Image size 1936x1296
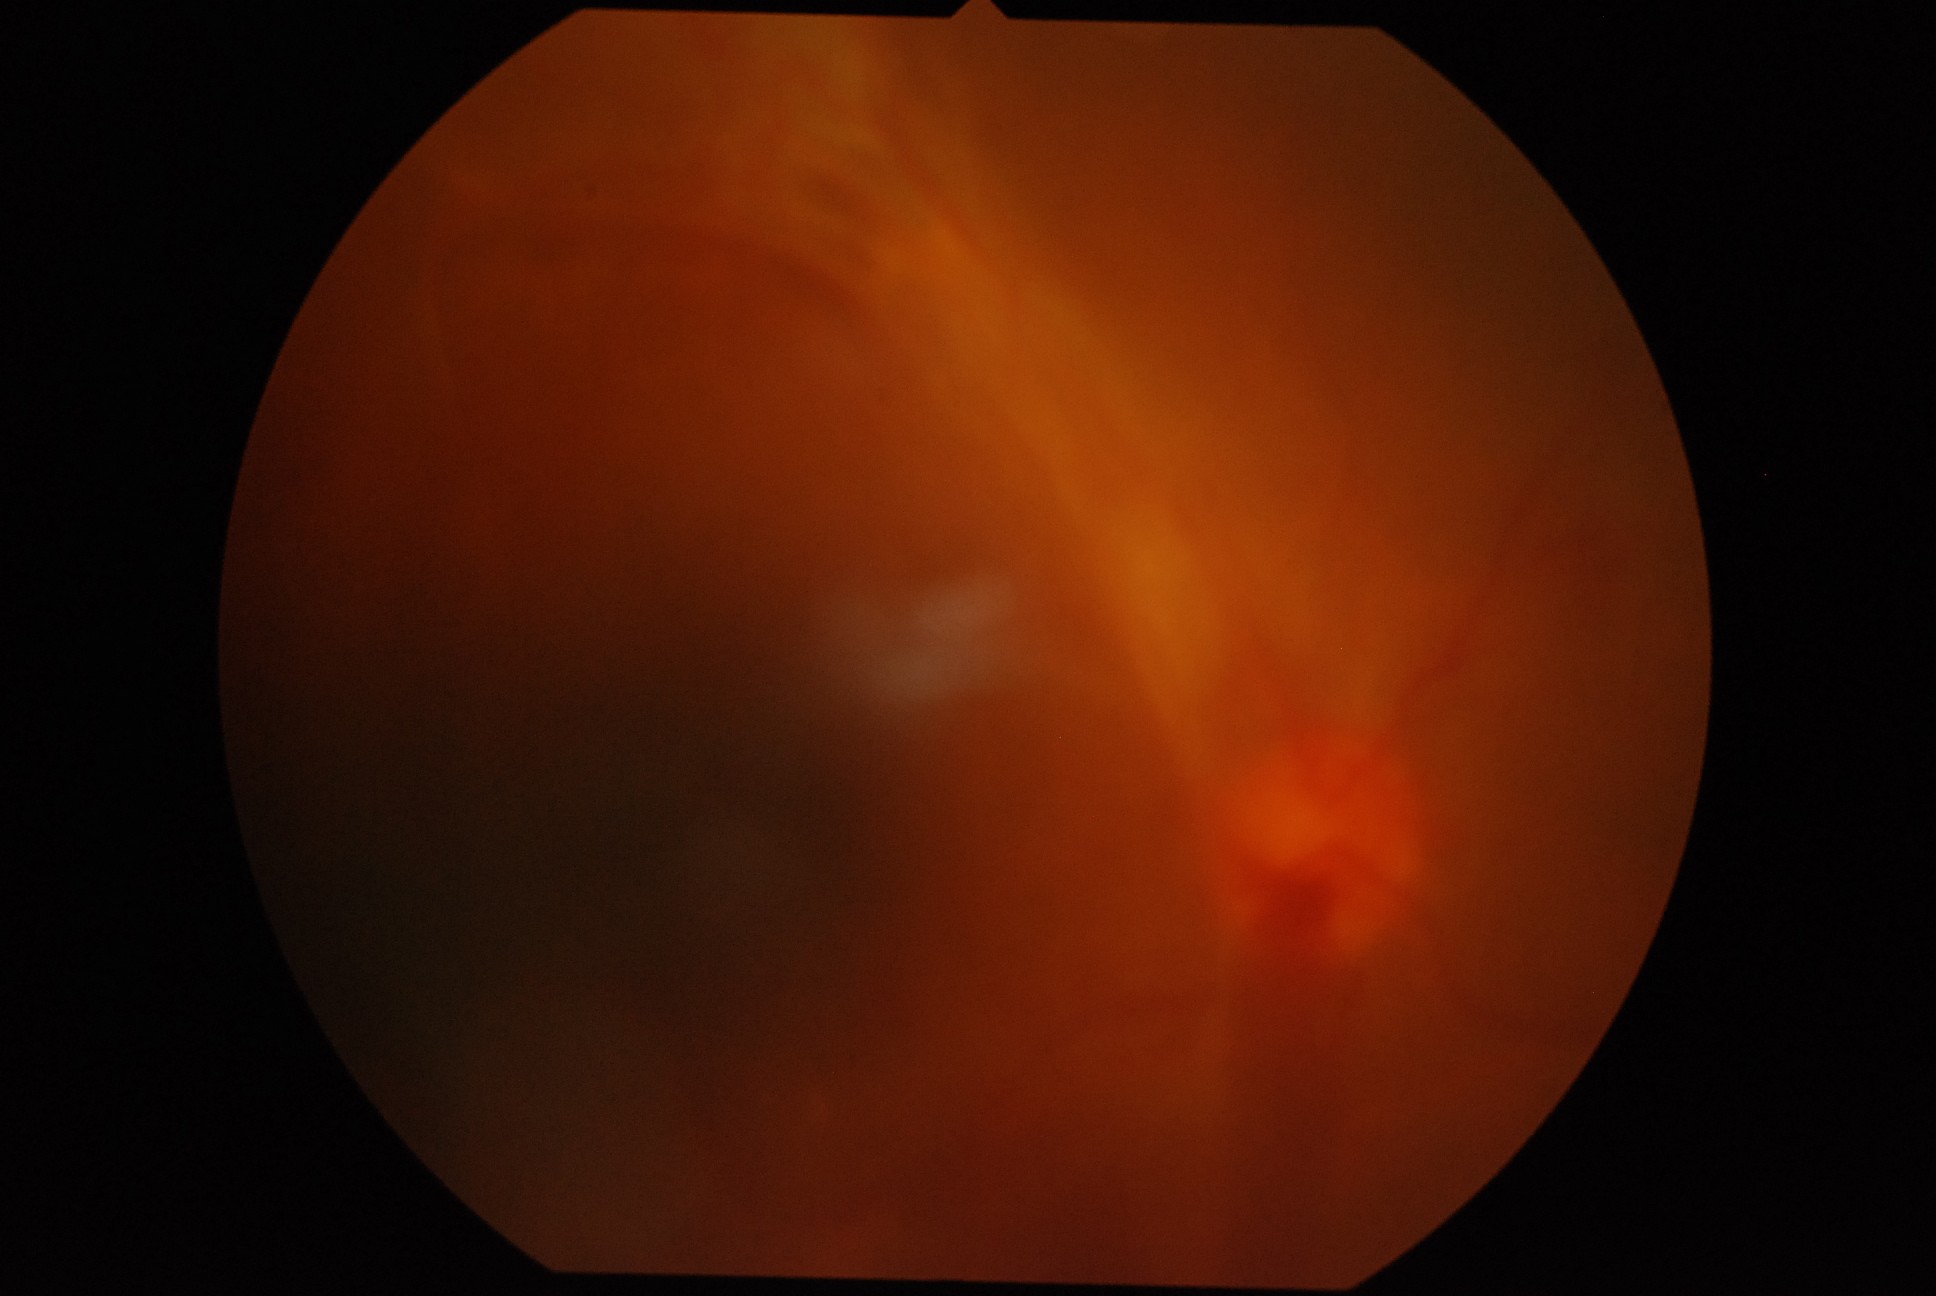

Retinopathy grade is proliferative diabetic retinopathy (4).